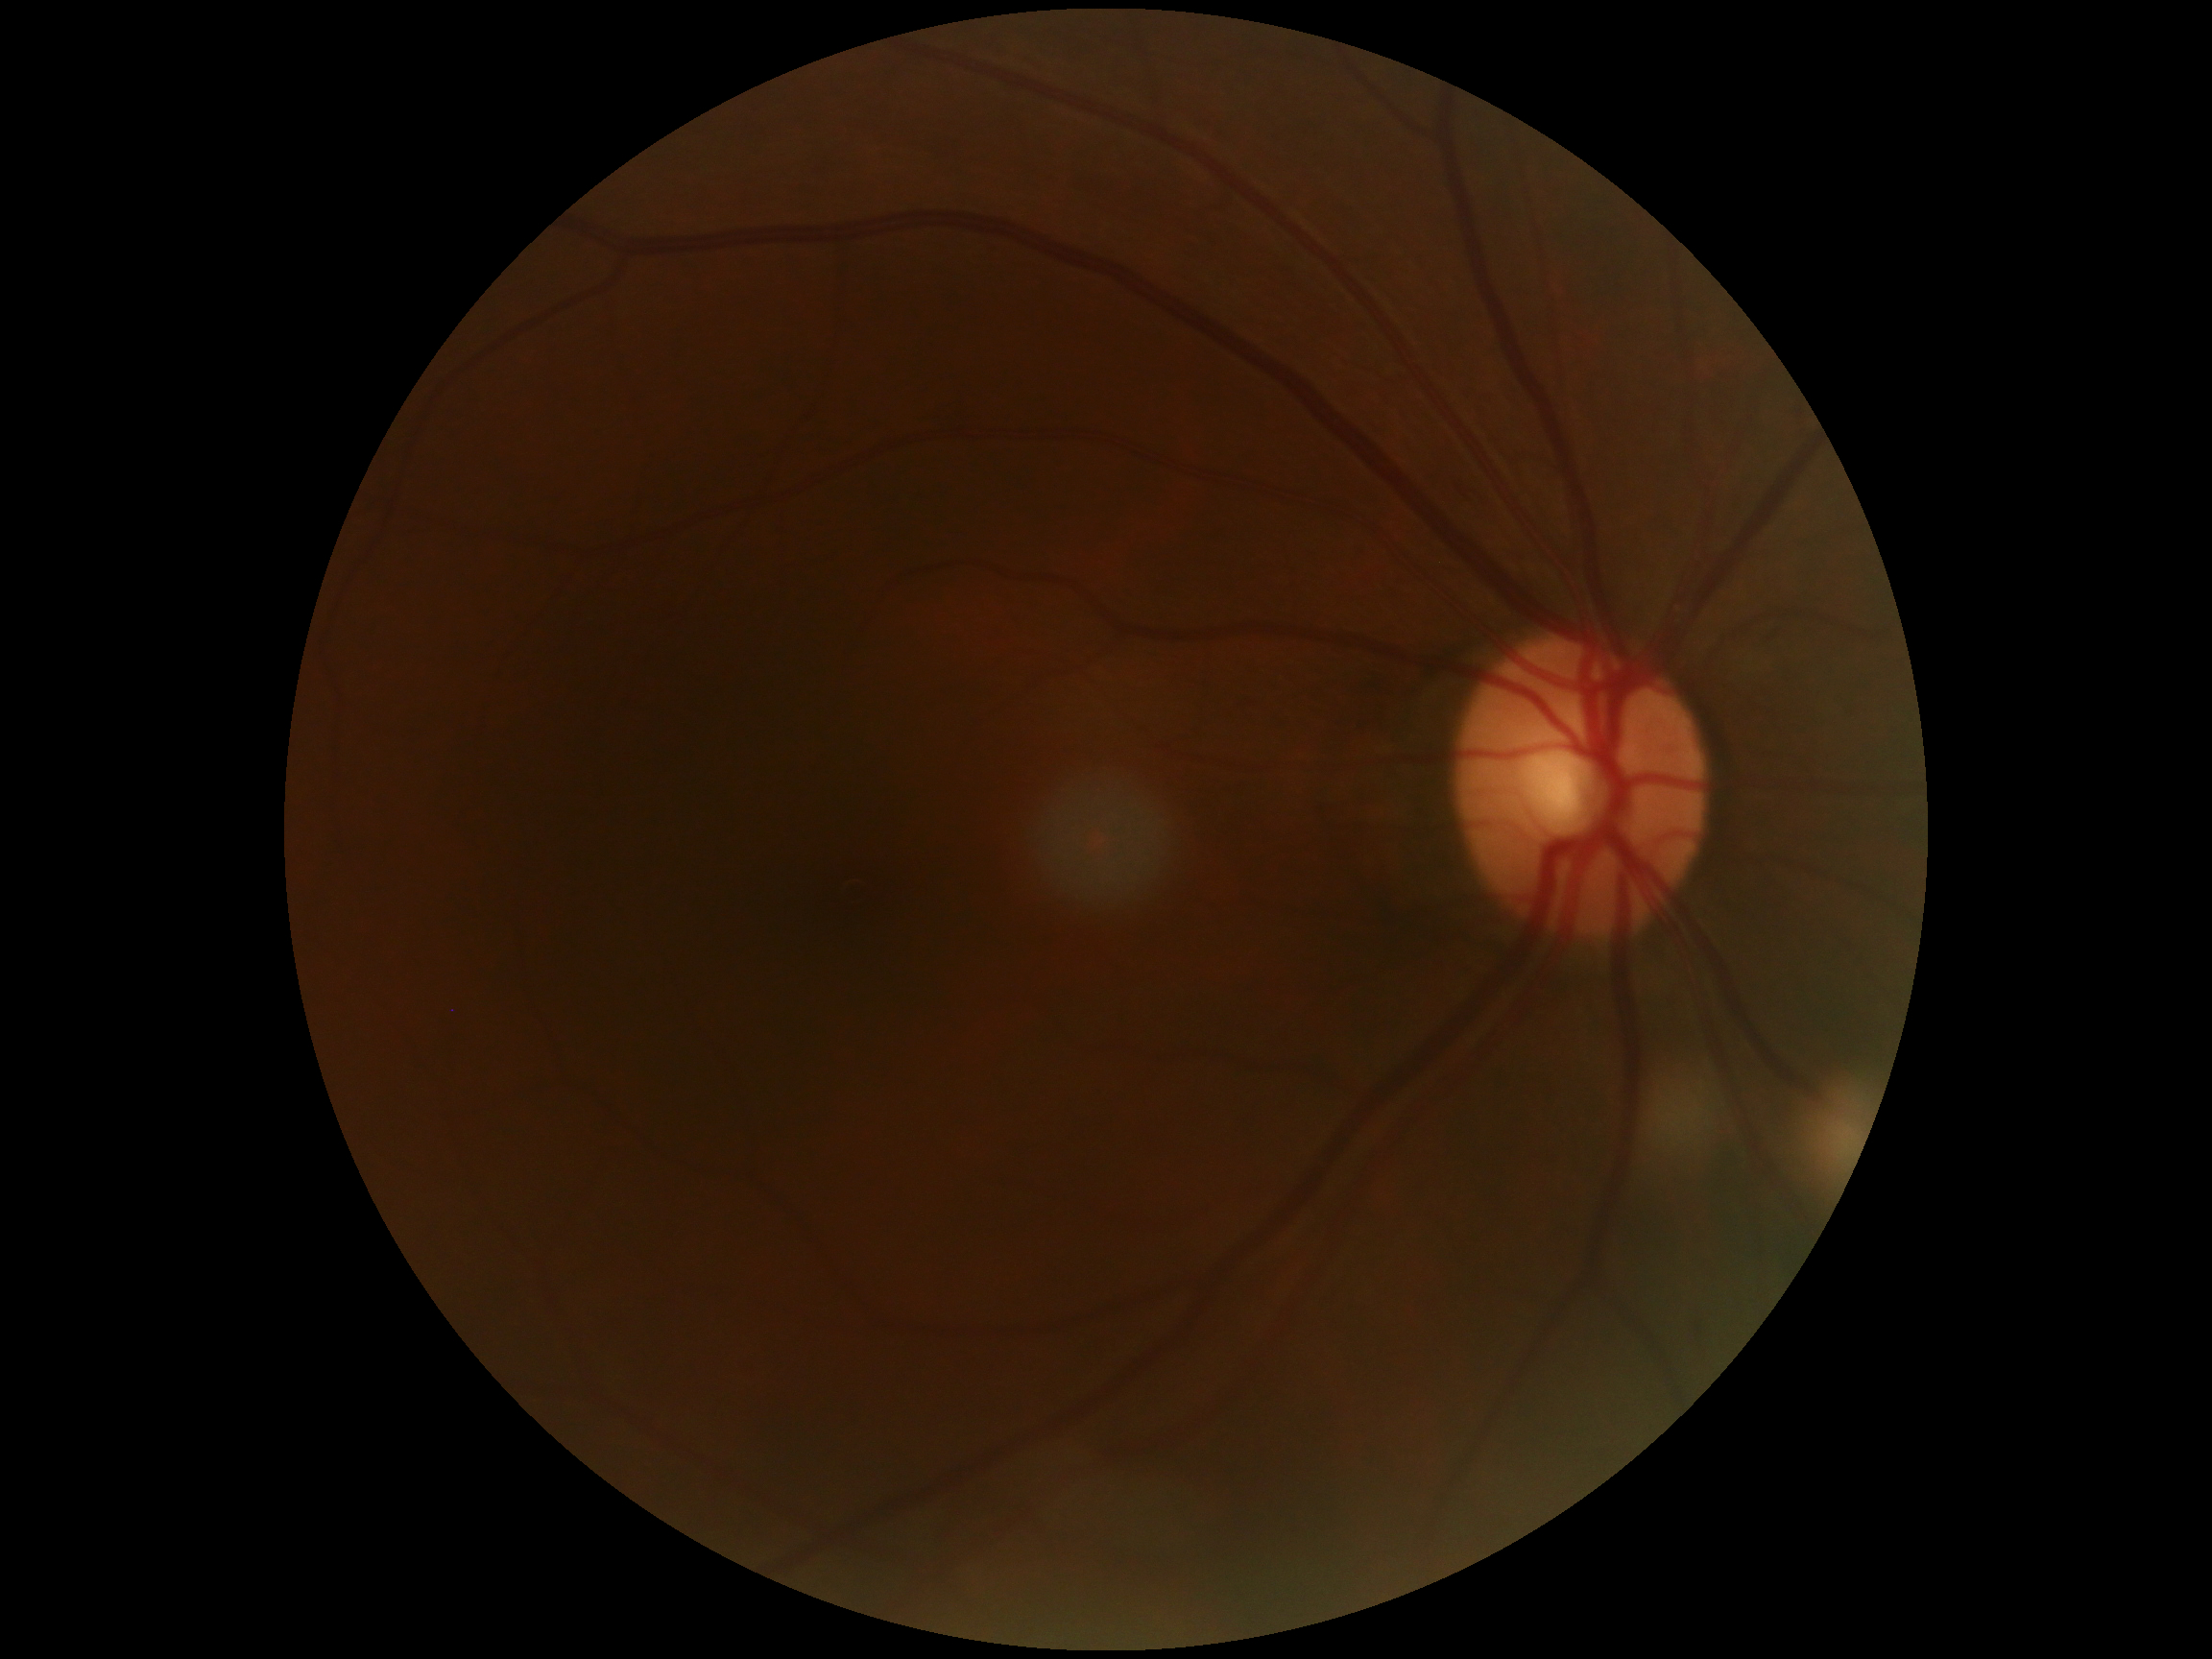

DR severity: moderate non-proliferative diabetic retinopathy (grade 2).